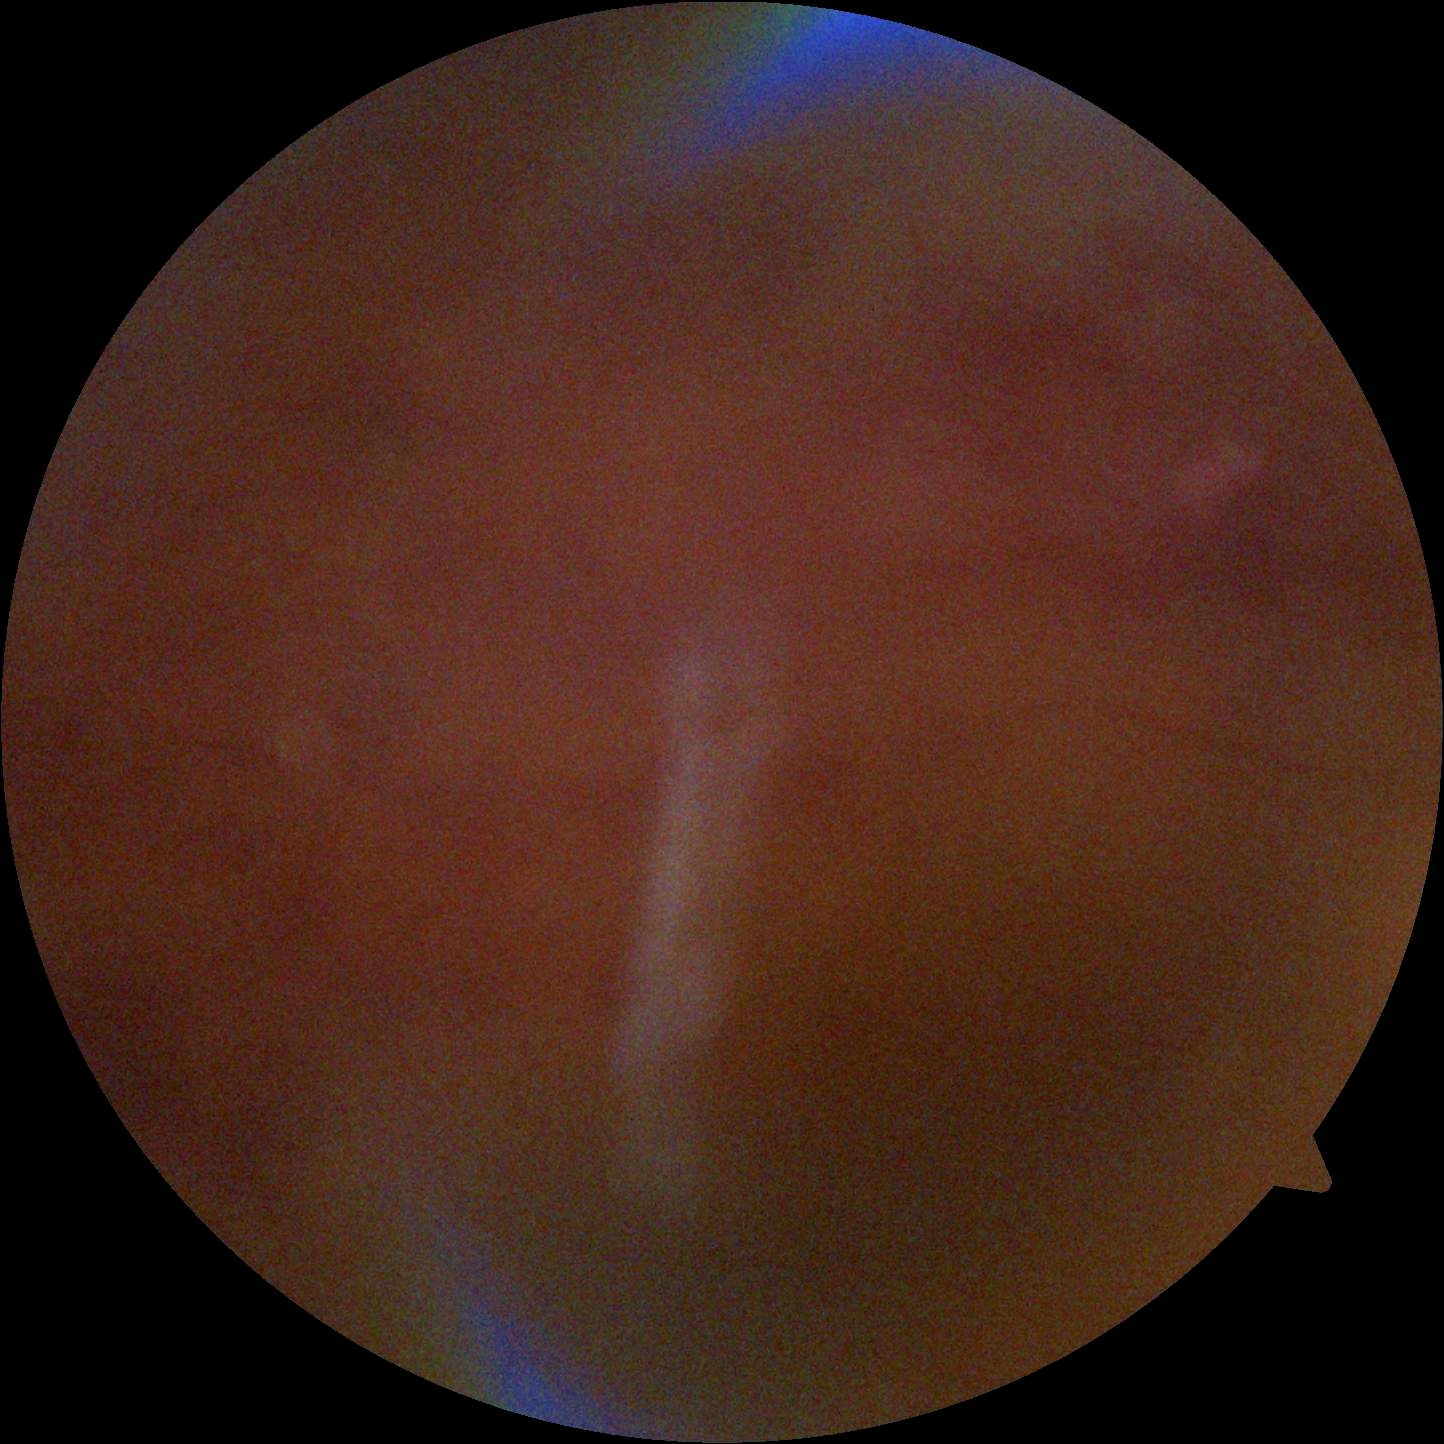

DR grade: ungradable due to poor image quality.